2346x1568 · color fundus photograph · 45-degree field of view
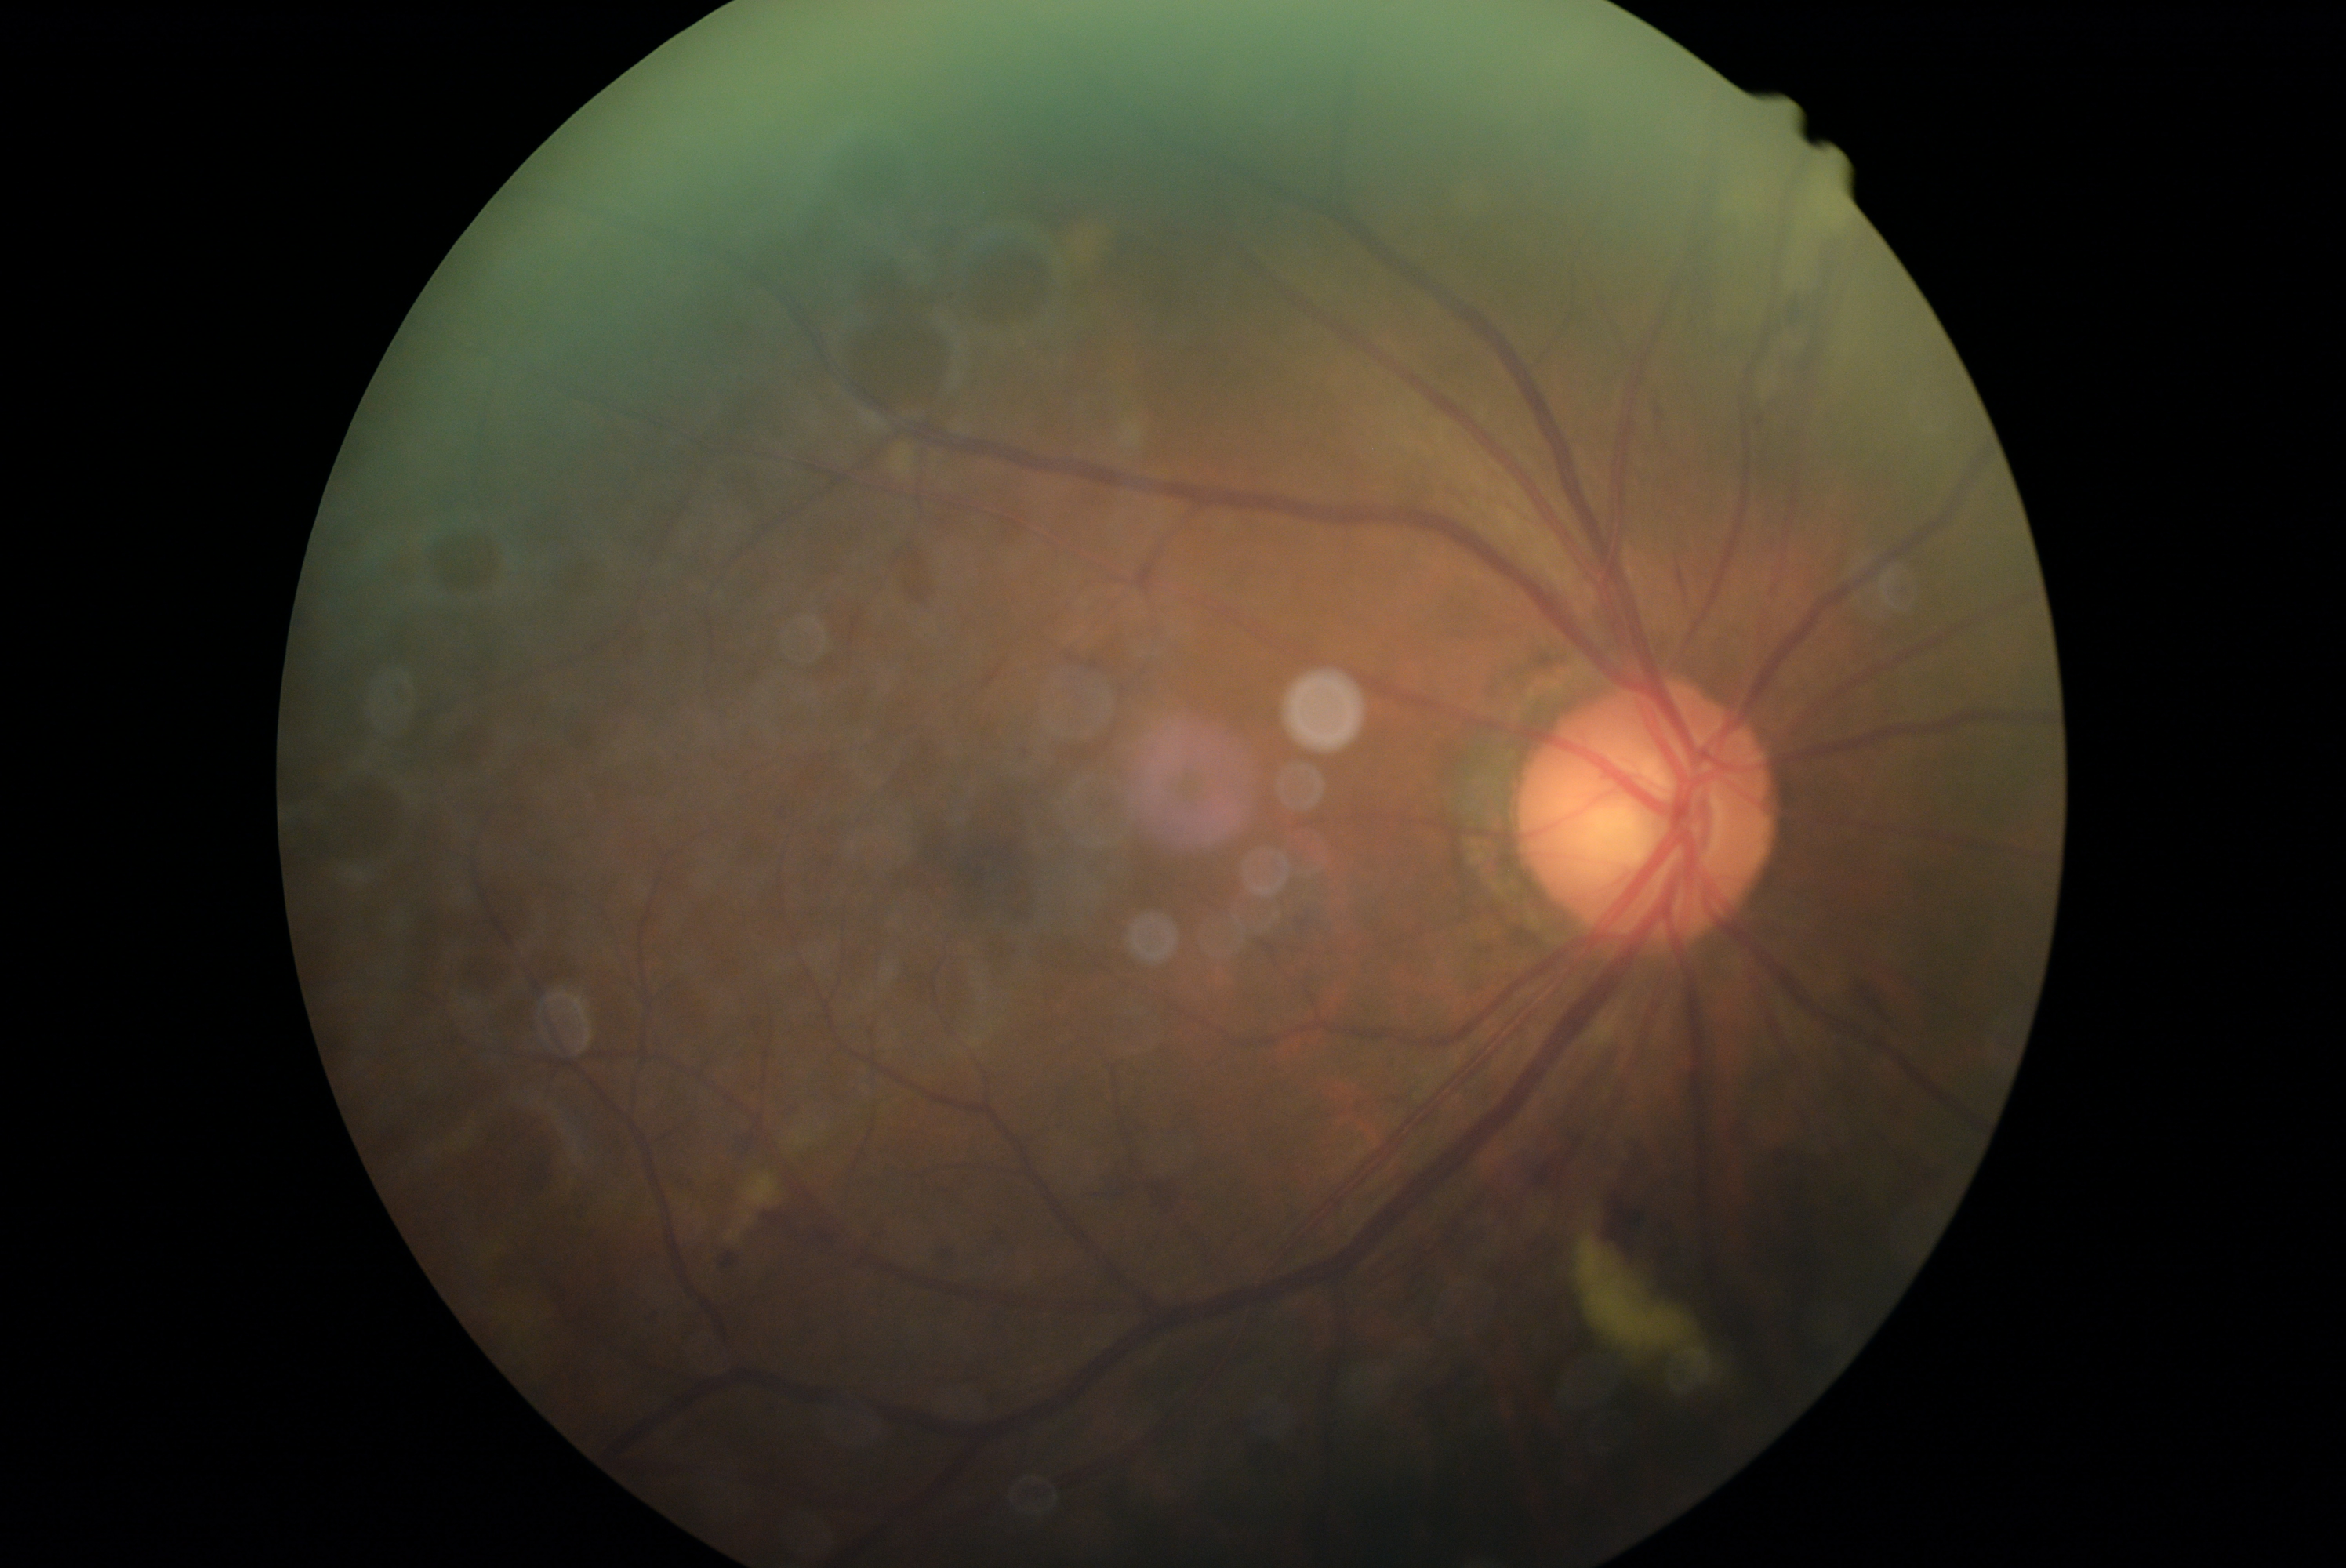
DR grade is moderate non-proliferative diabetic retinopathy (2).